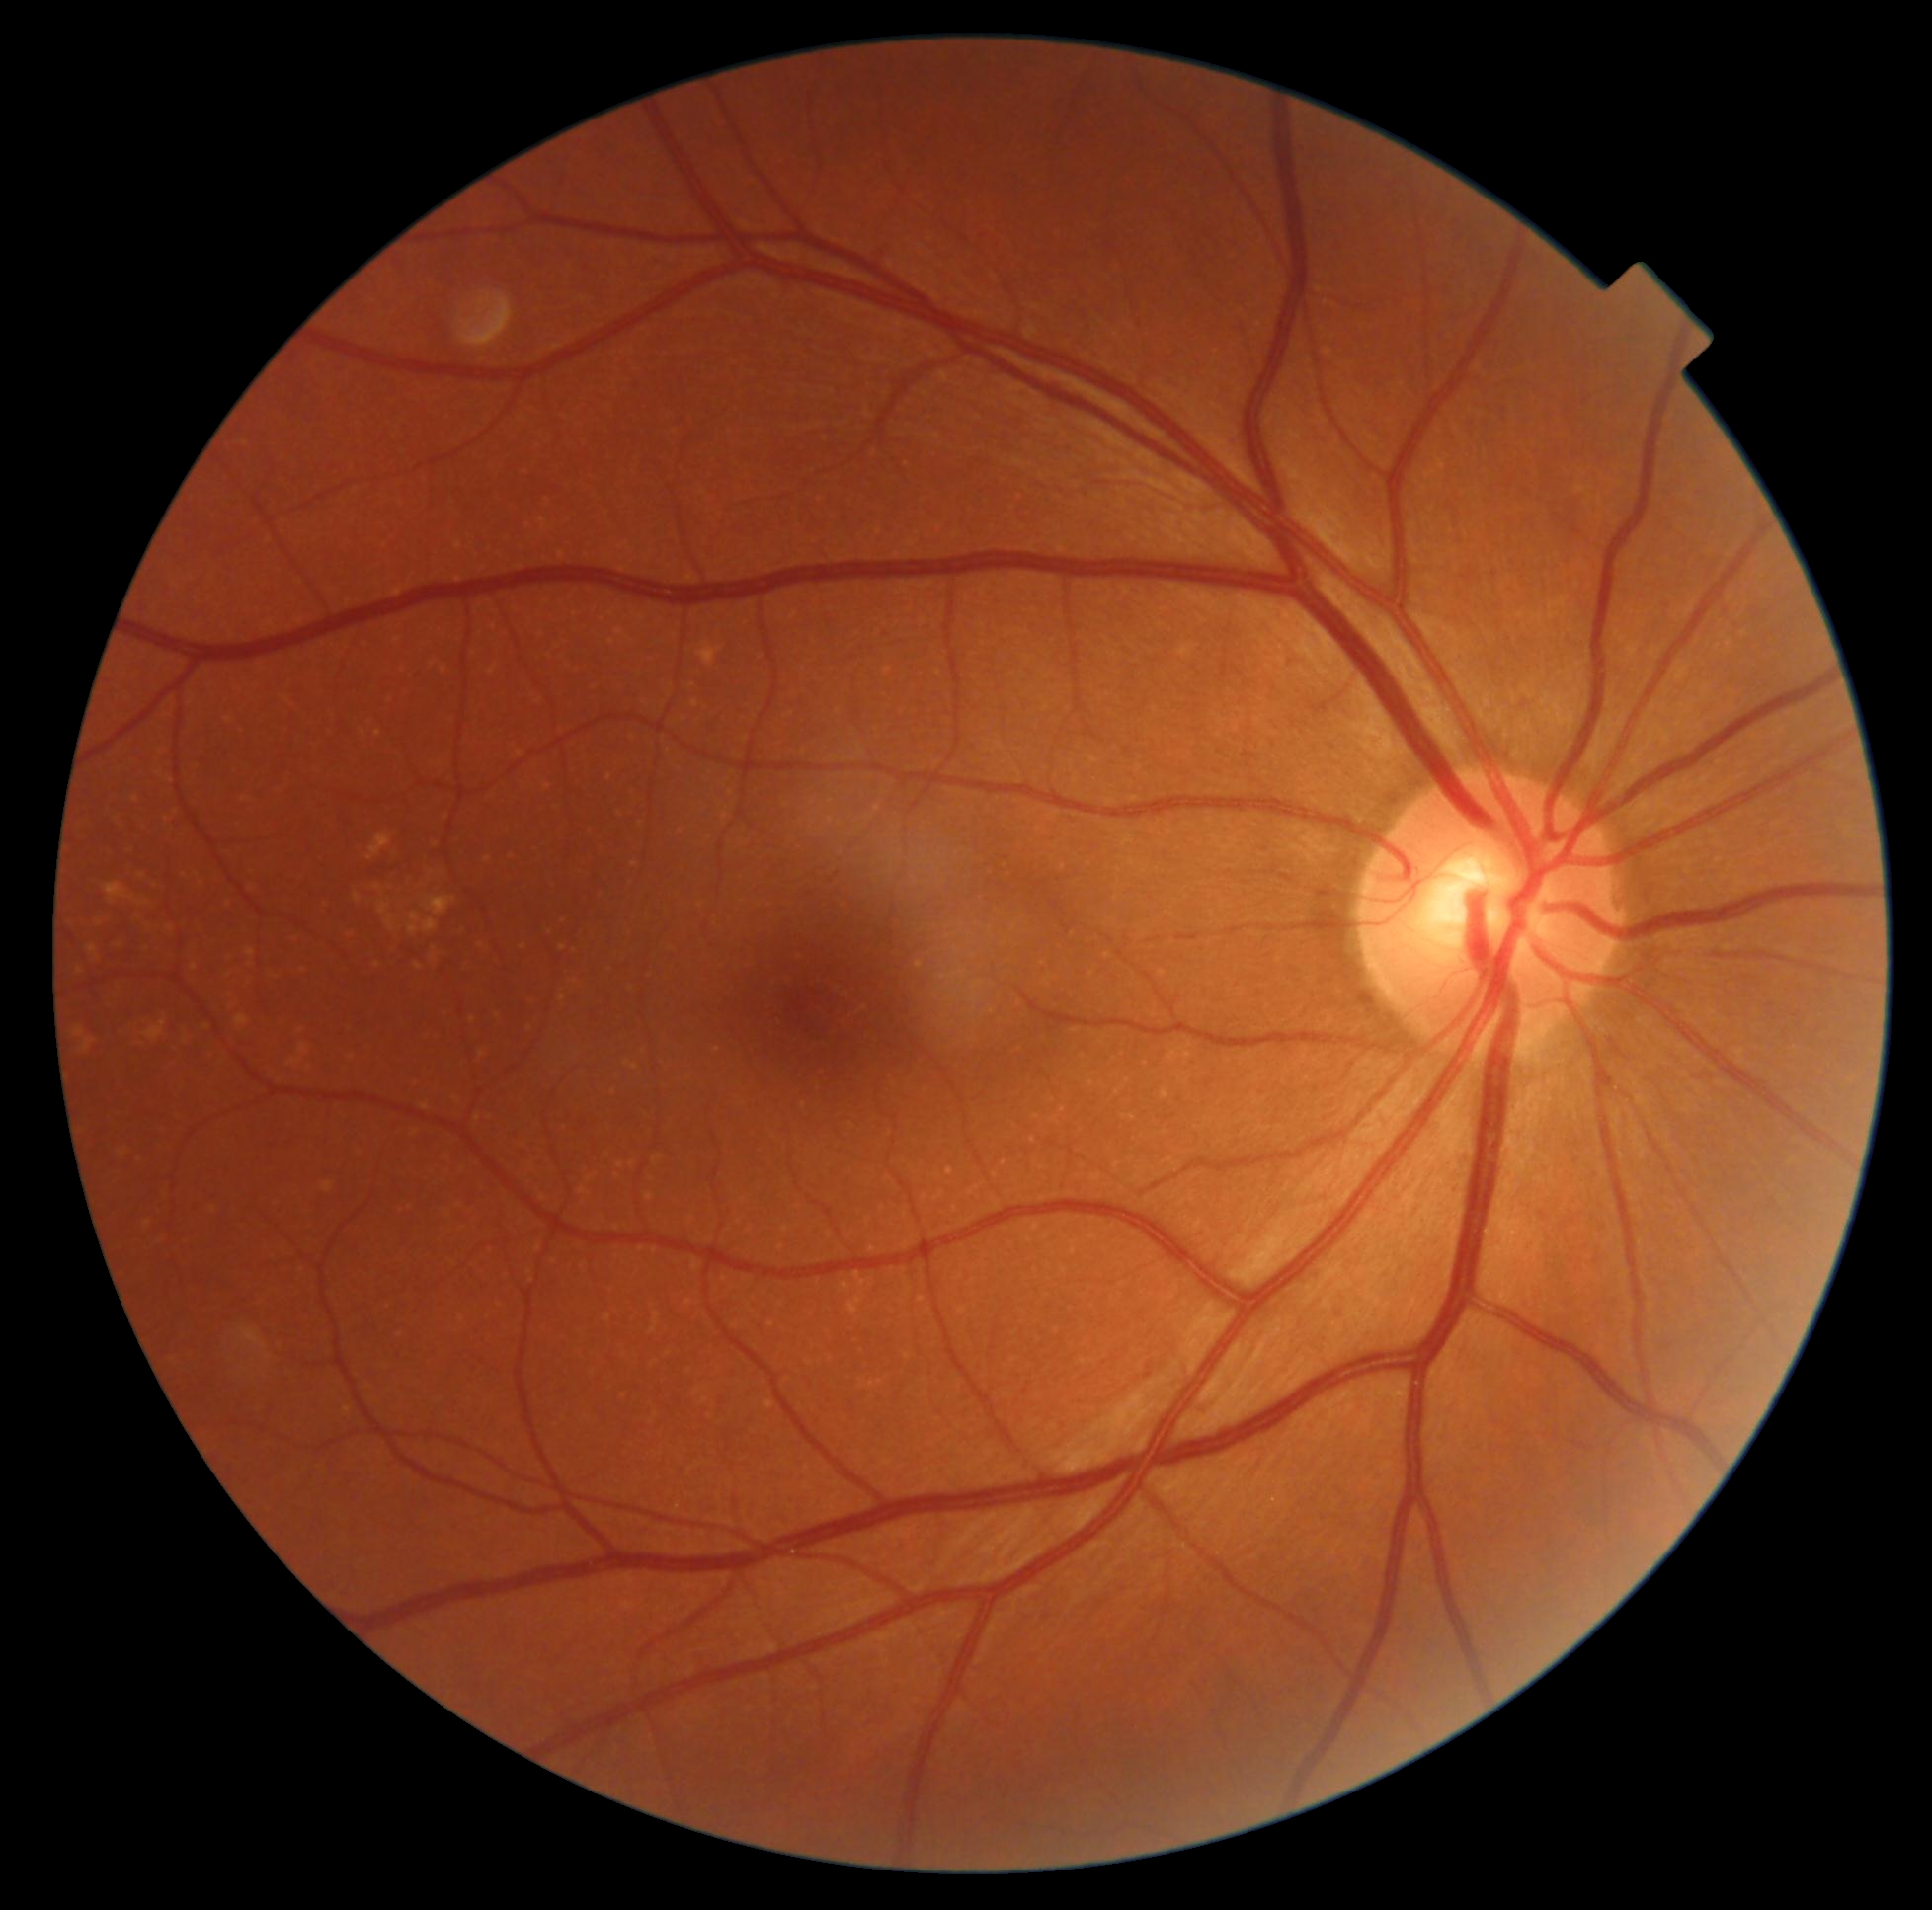
DR: 0.